Ultra-widefield fundus photograph: 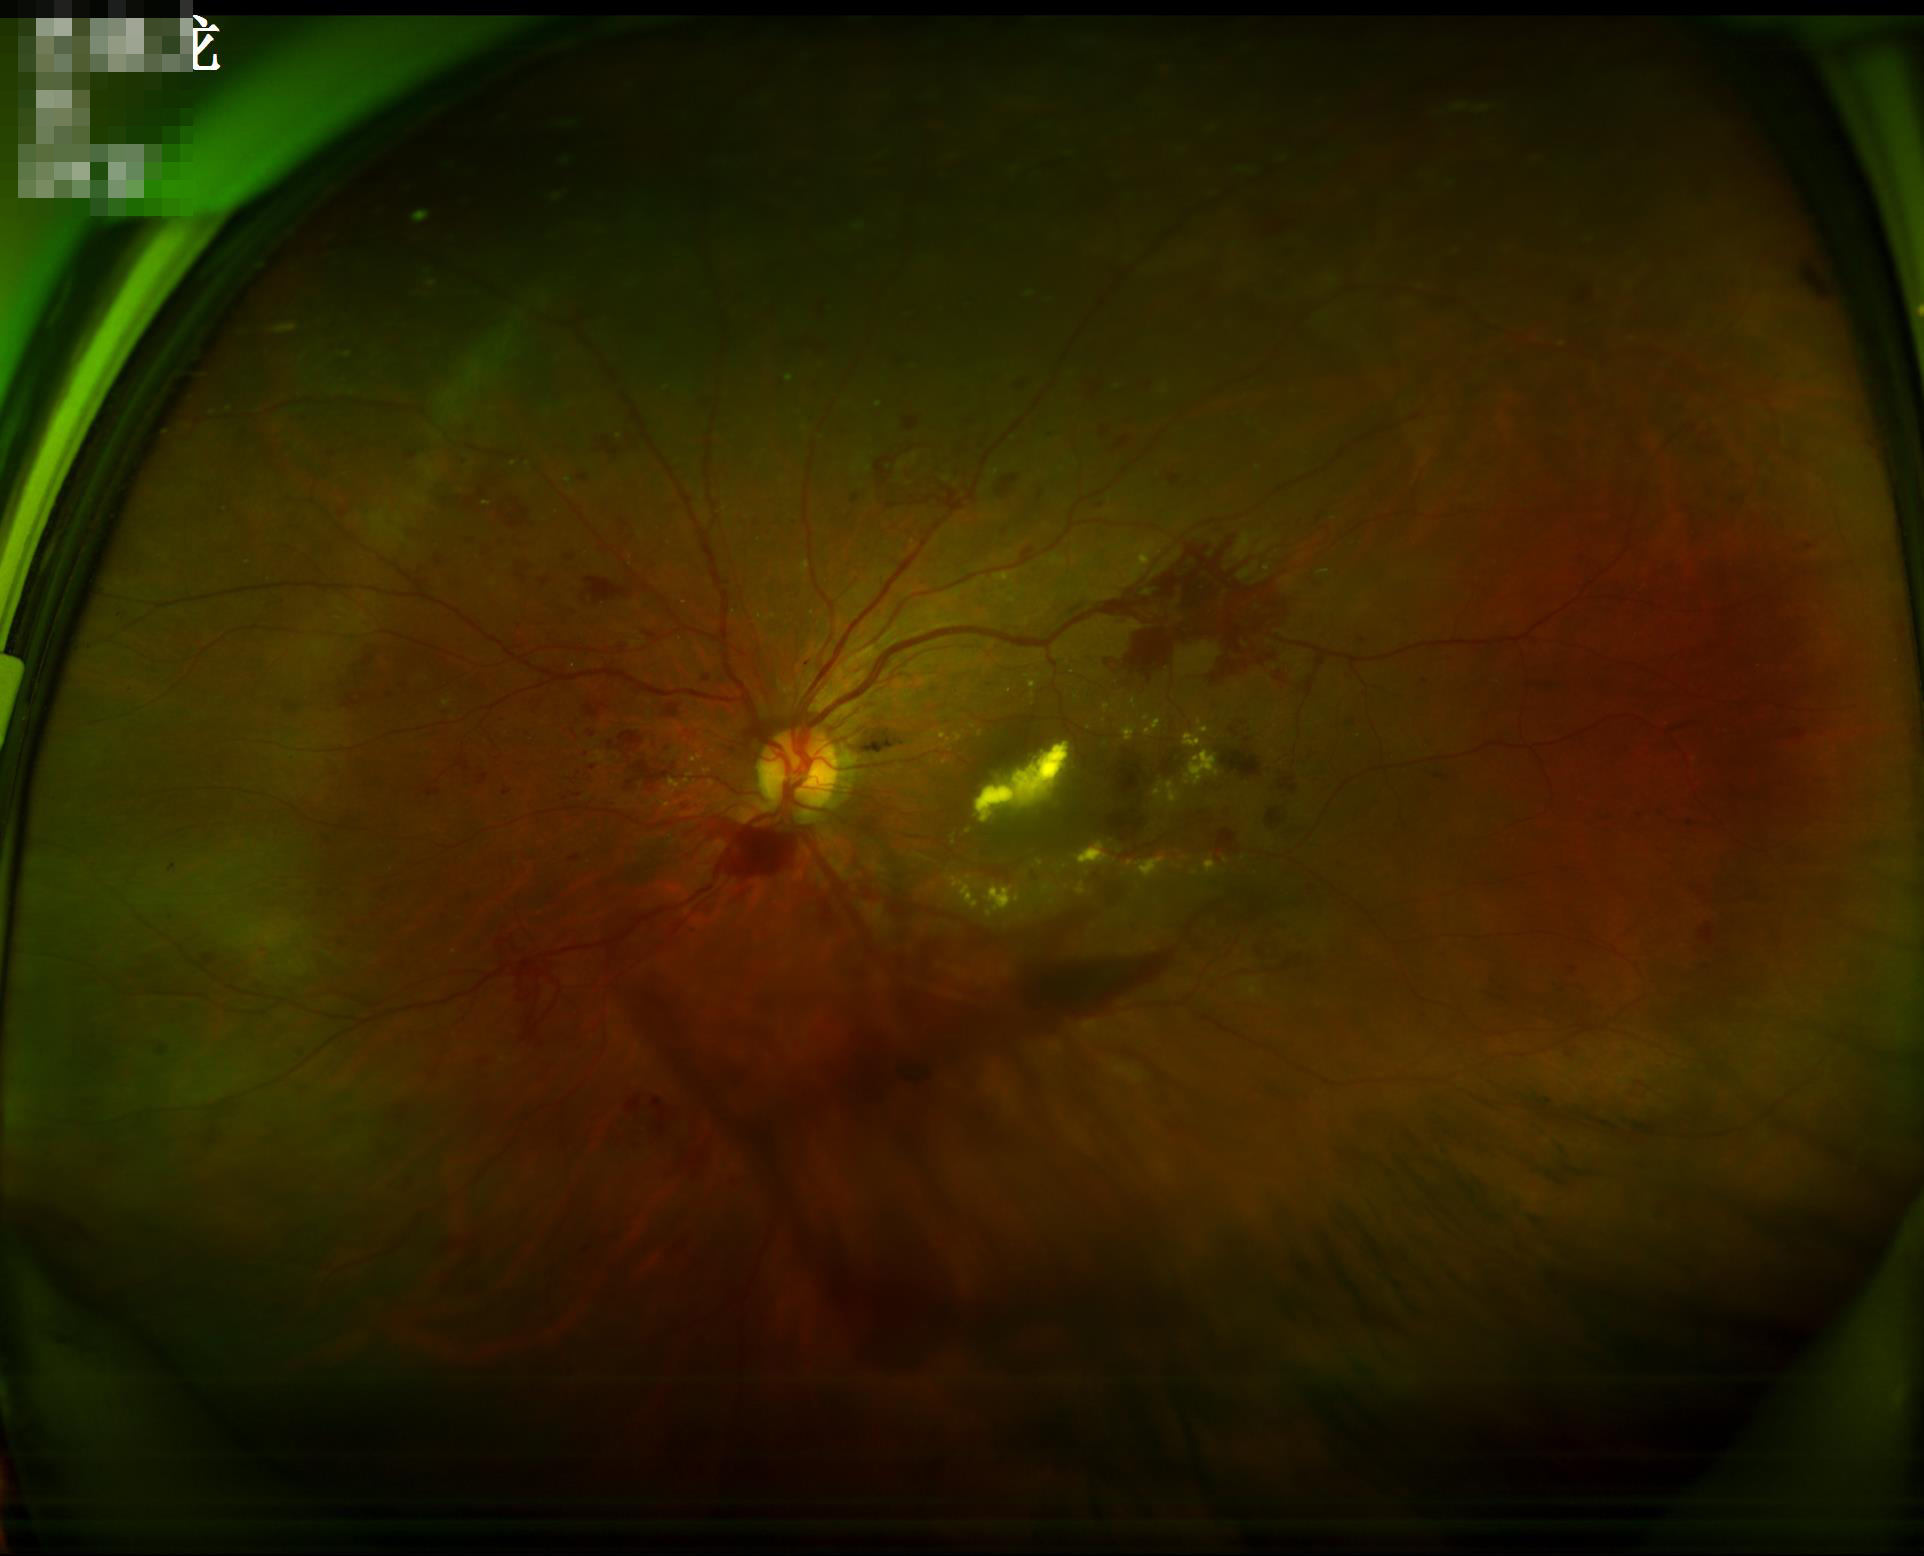

Illumination is uneven.
Image is sharp throughout the field.
Acceptable image quality.
Adequate contrast for distinguishing structures.